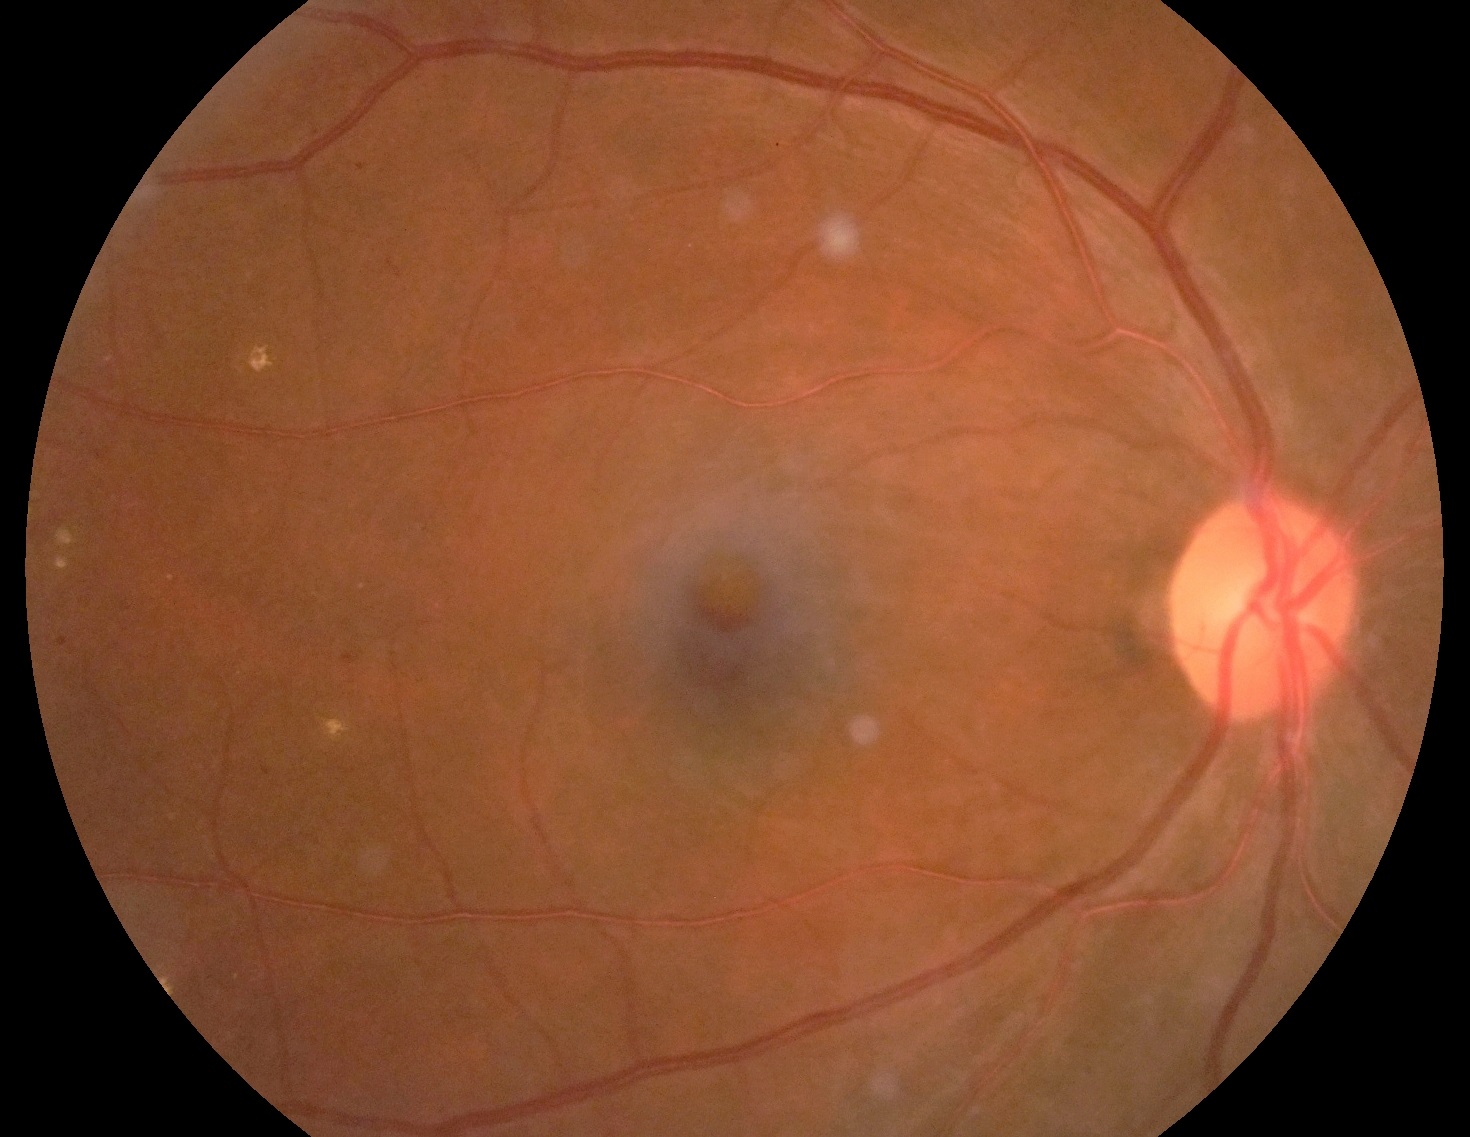

DR class: non-proliferative diabetic retinopathy. DR severity is grade 2 (moderate NPDR) — more than just microaneurysms but less than severe NPDR.